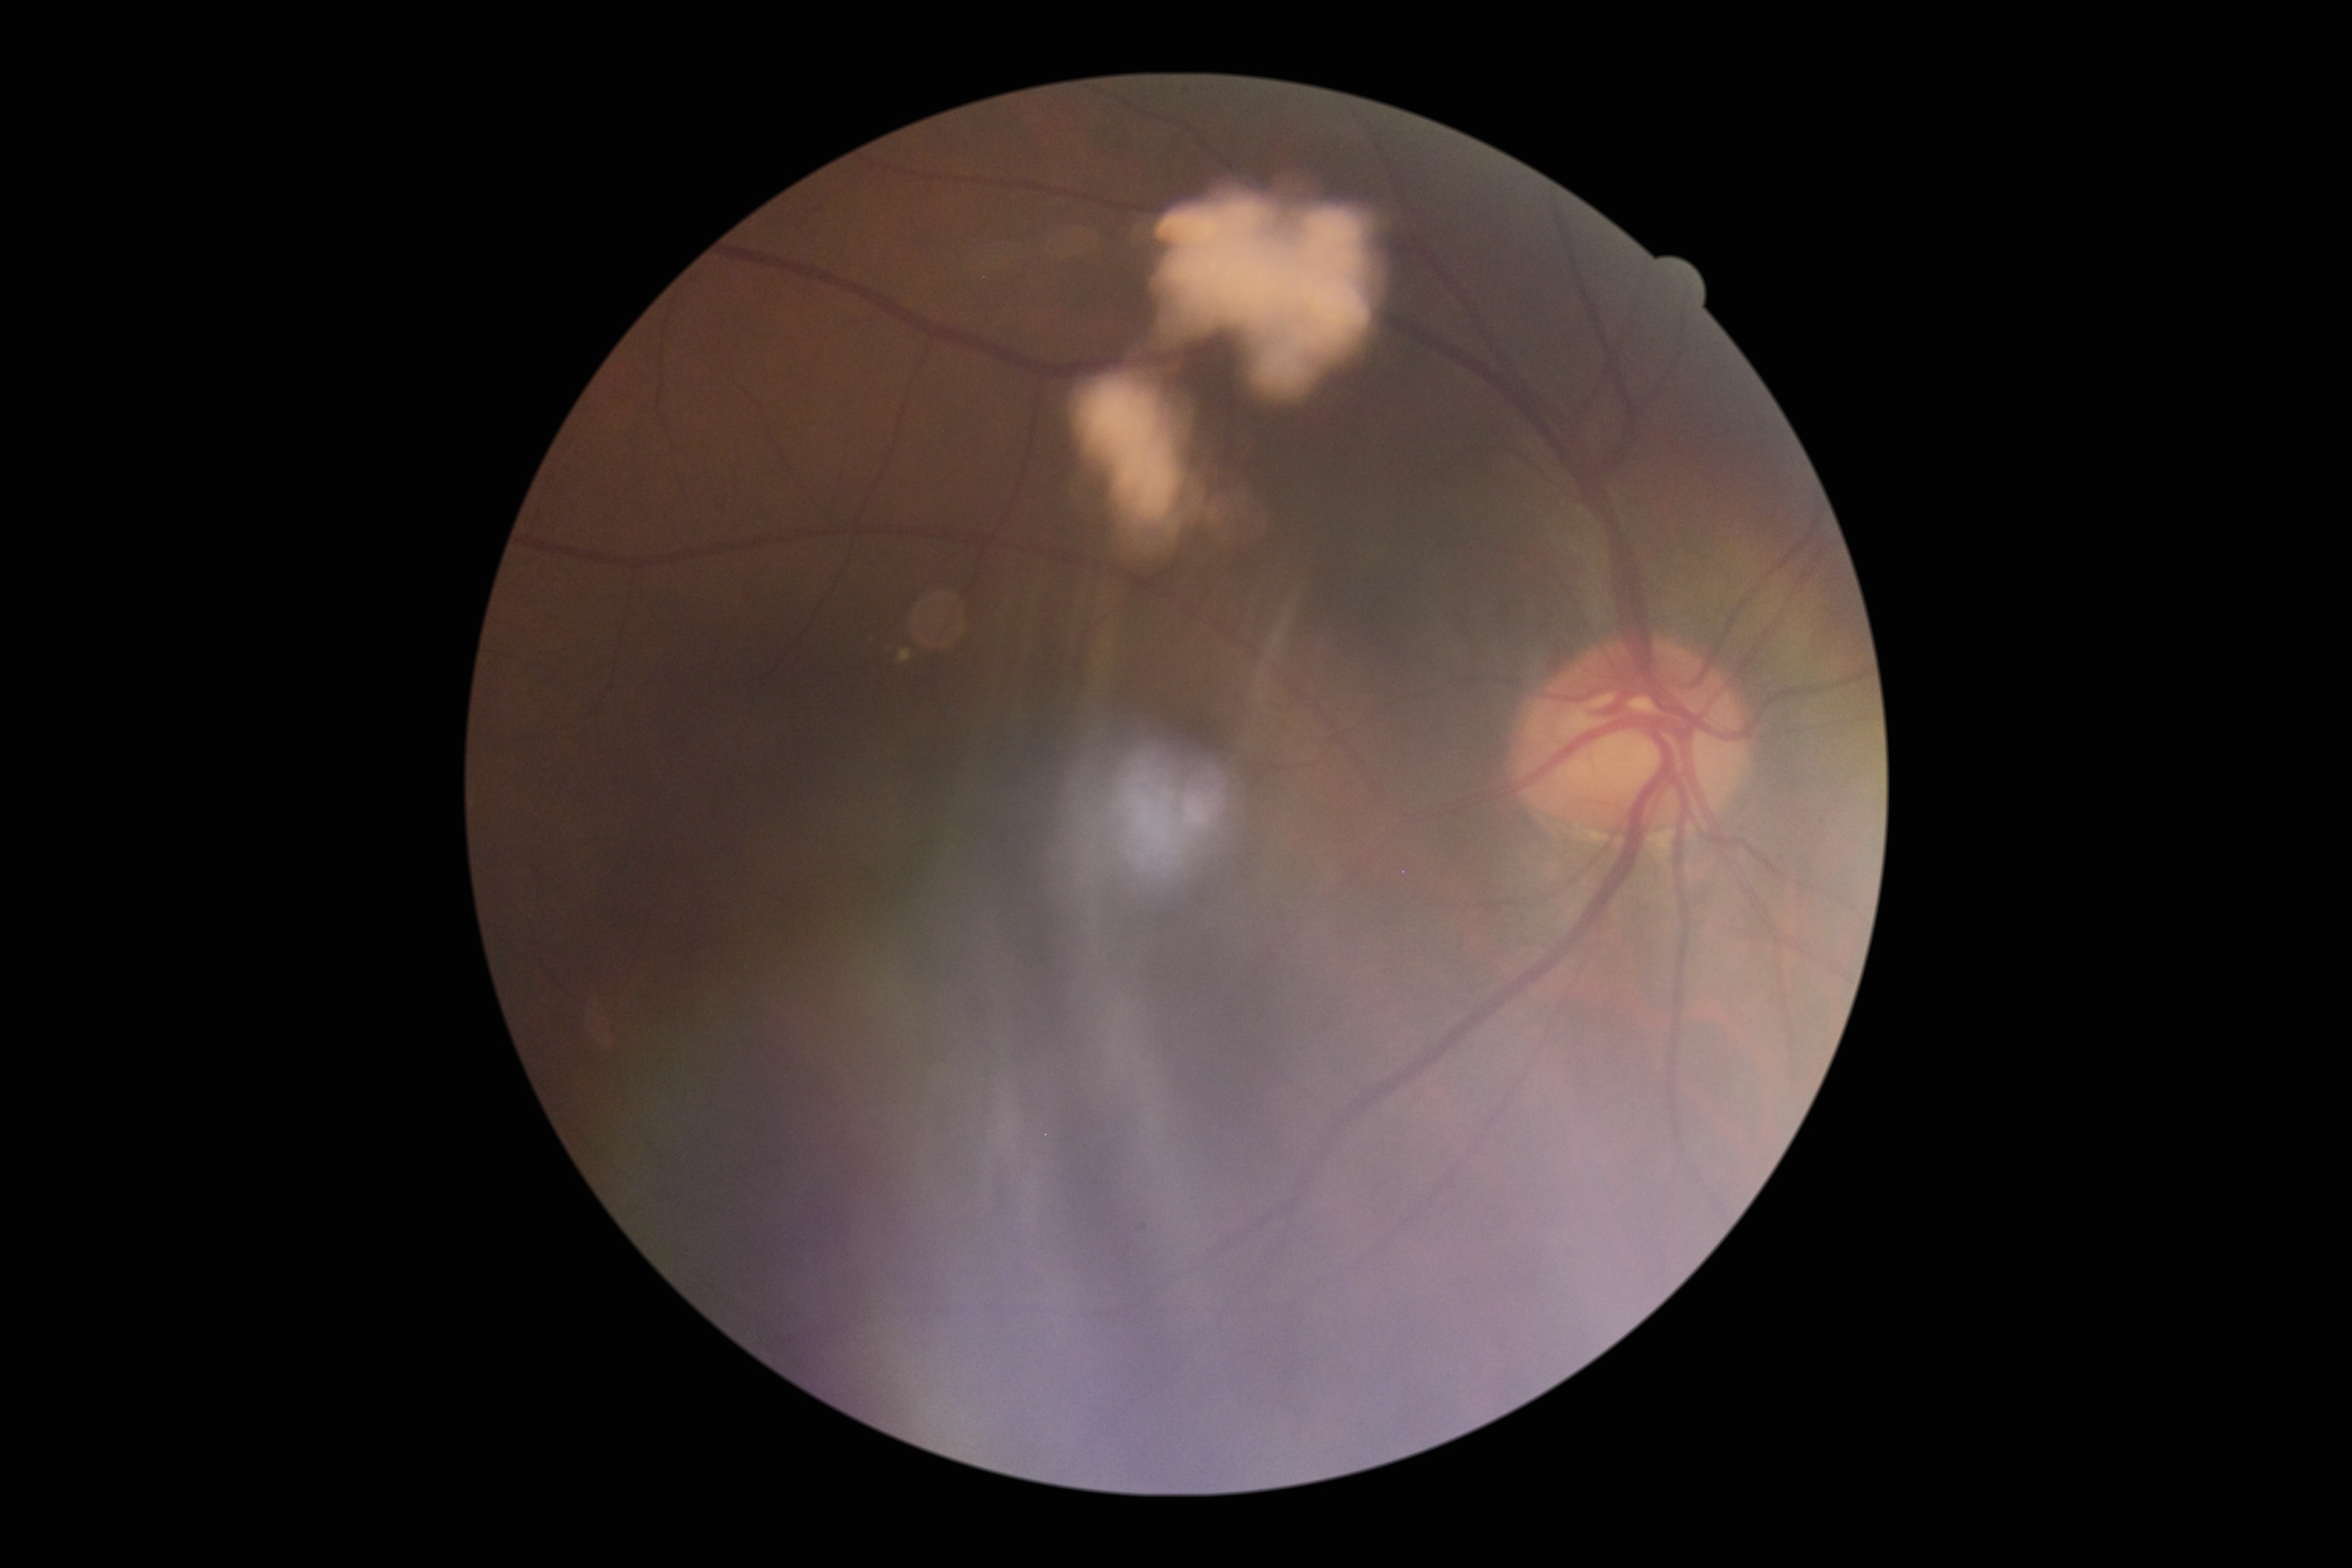 Annotations:
• DR stage: 2